Pediatric wide-field fundus photograph — 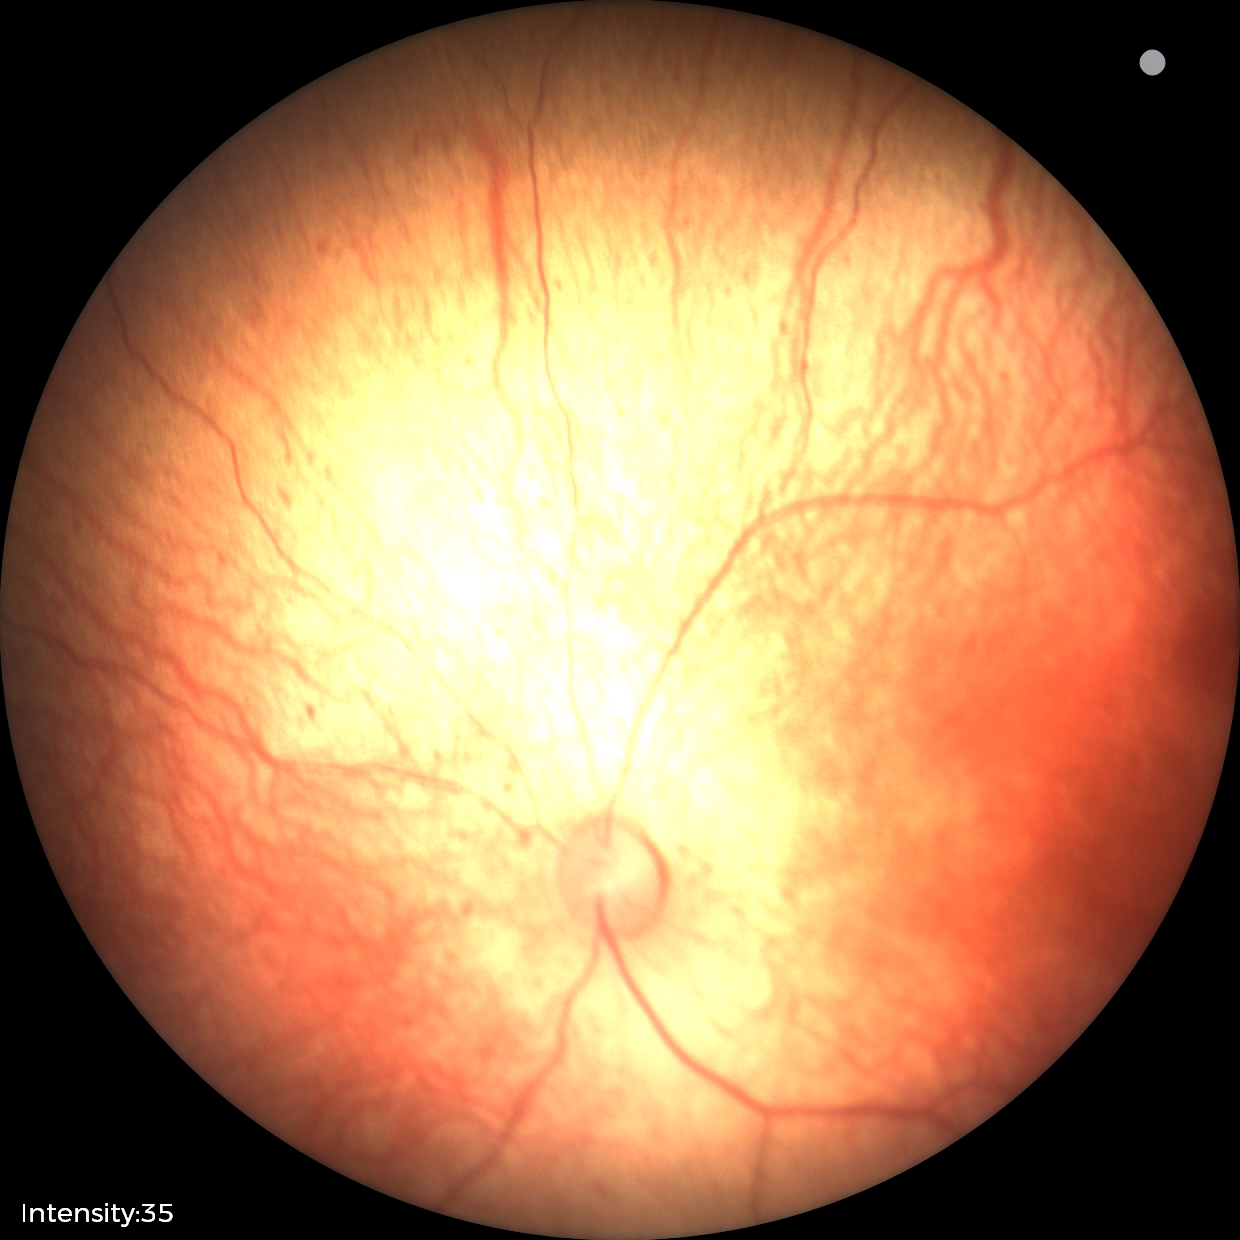

Diagnosis = status post retinopathy of prematurity (ROP).